45 degree fundus photograph, 848x848, graded on the modified Davis scale
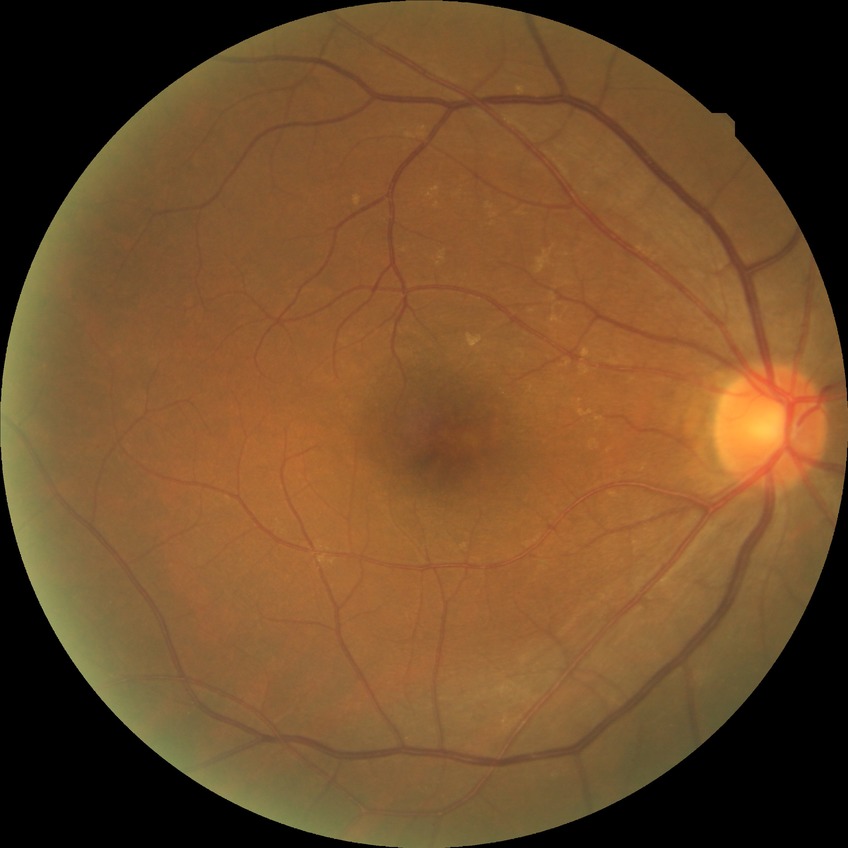
DR stage@NDR.